848x848: 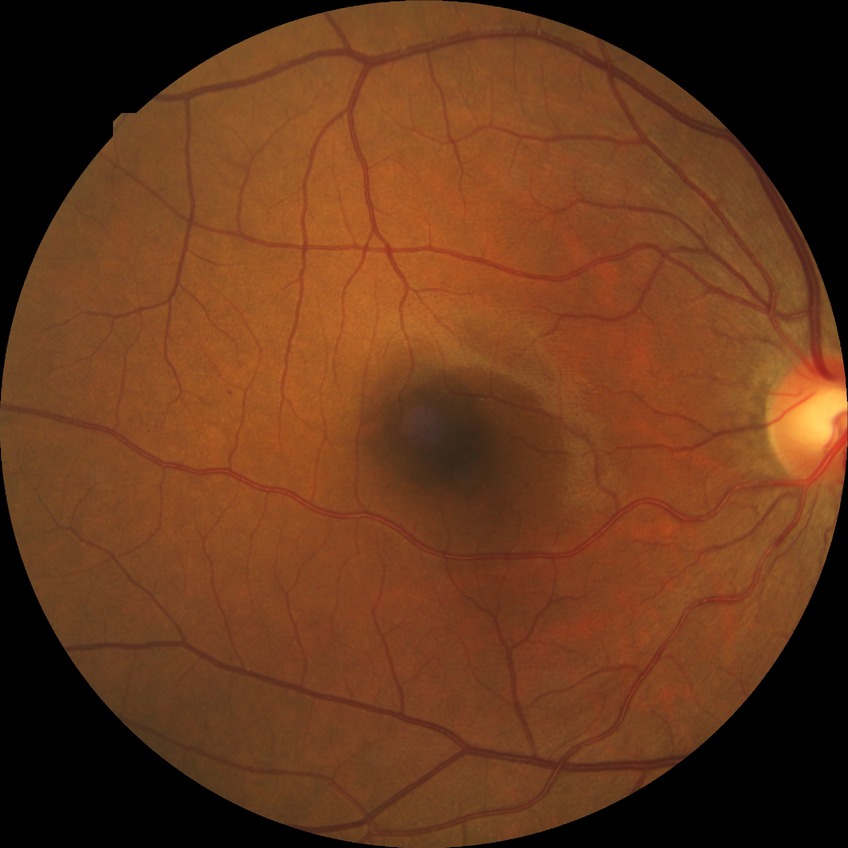 {"davis_grade": "simple diabetic retinopathy (SDR)", "proliferative_class": "non-proliferative diabetic retinopathy"}